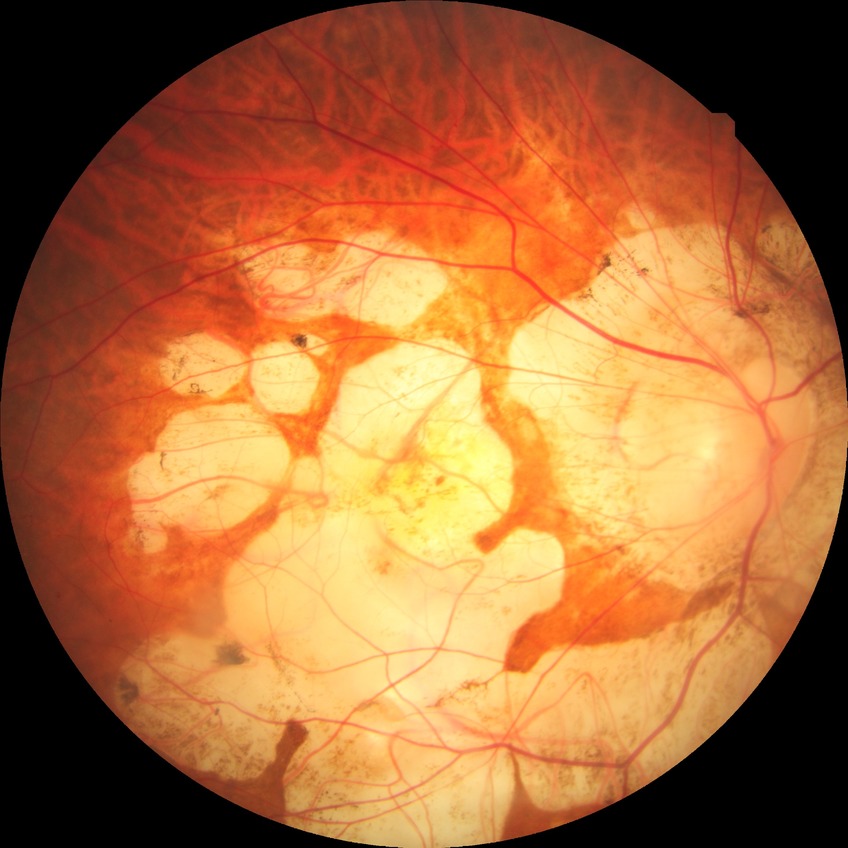
diabetic retinopathy severity = no diabetic retinopathy.